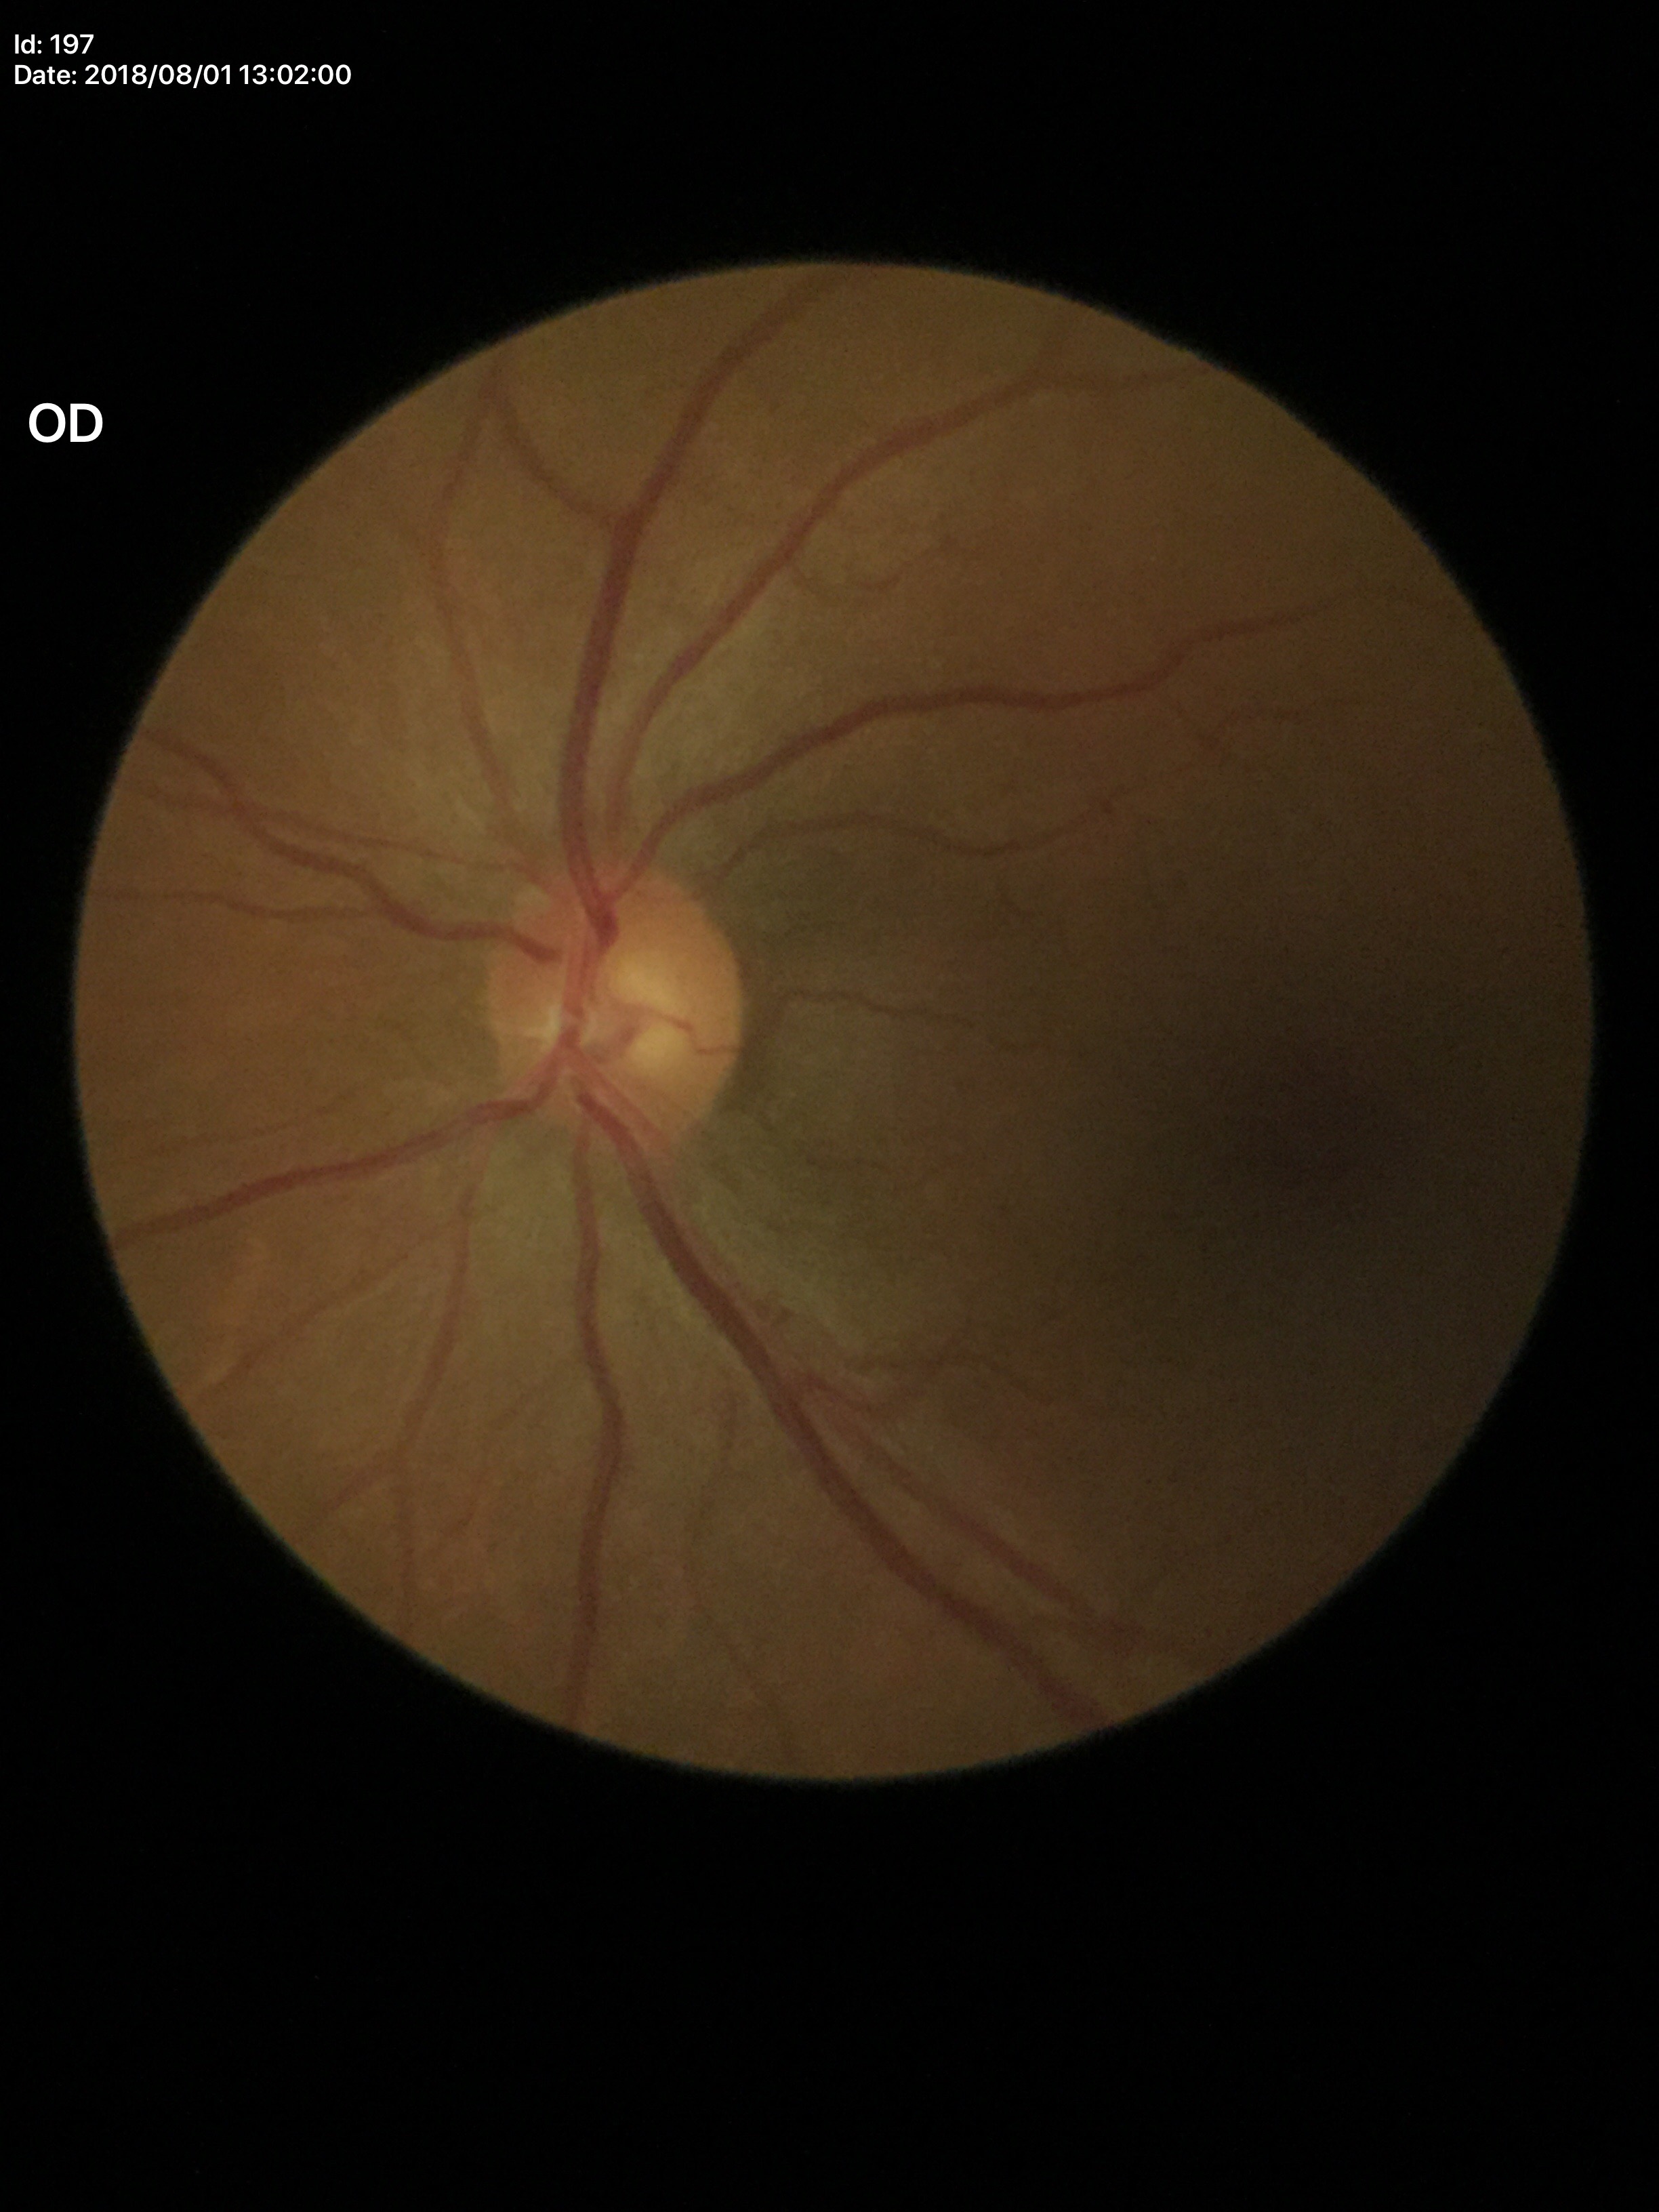 Q: What is the area cup-to-disc ratio?
A: 0.27
Q: Glaucoma screening result?
A: negative
Q: What is the VCDR?
A: 0.49